Retinal fundus photograph; 2346x1568px; 45-degree field of view.
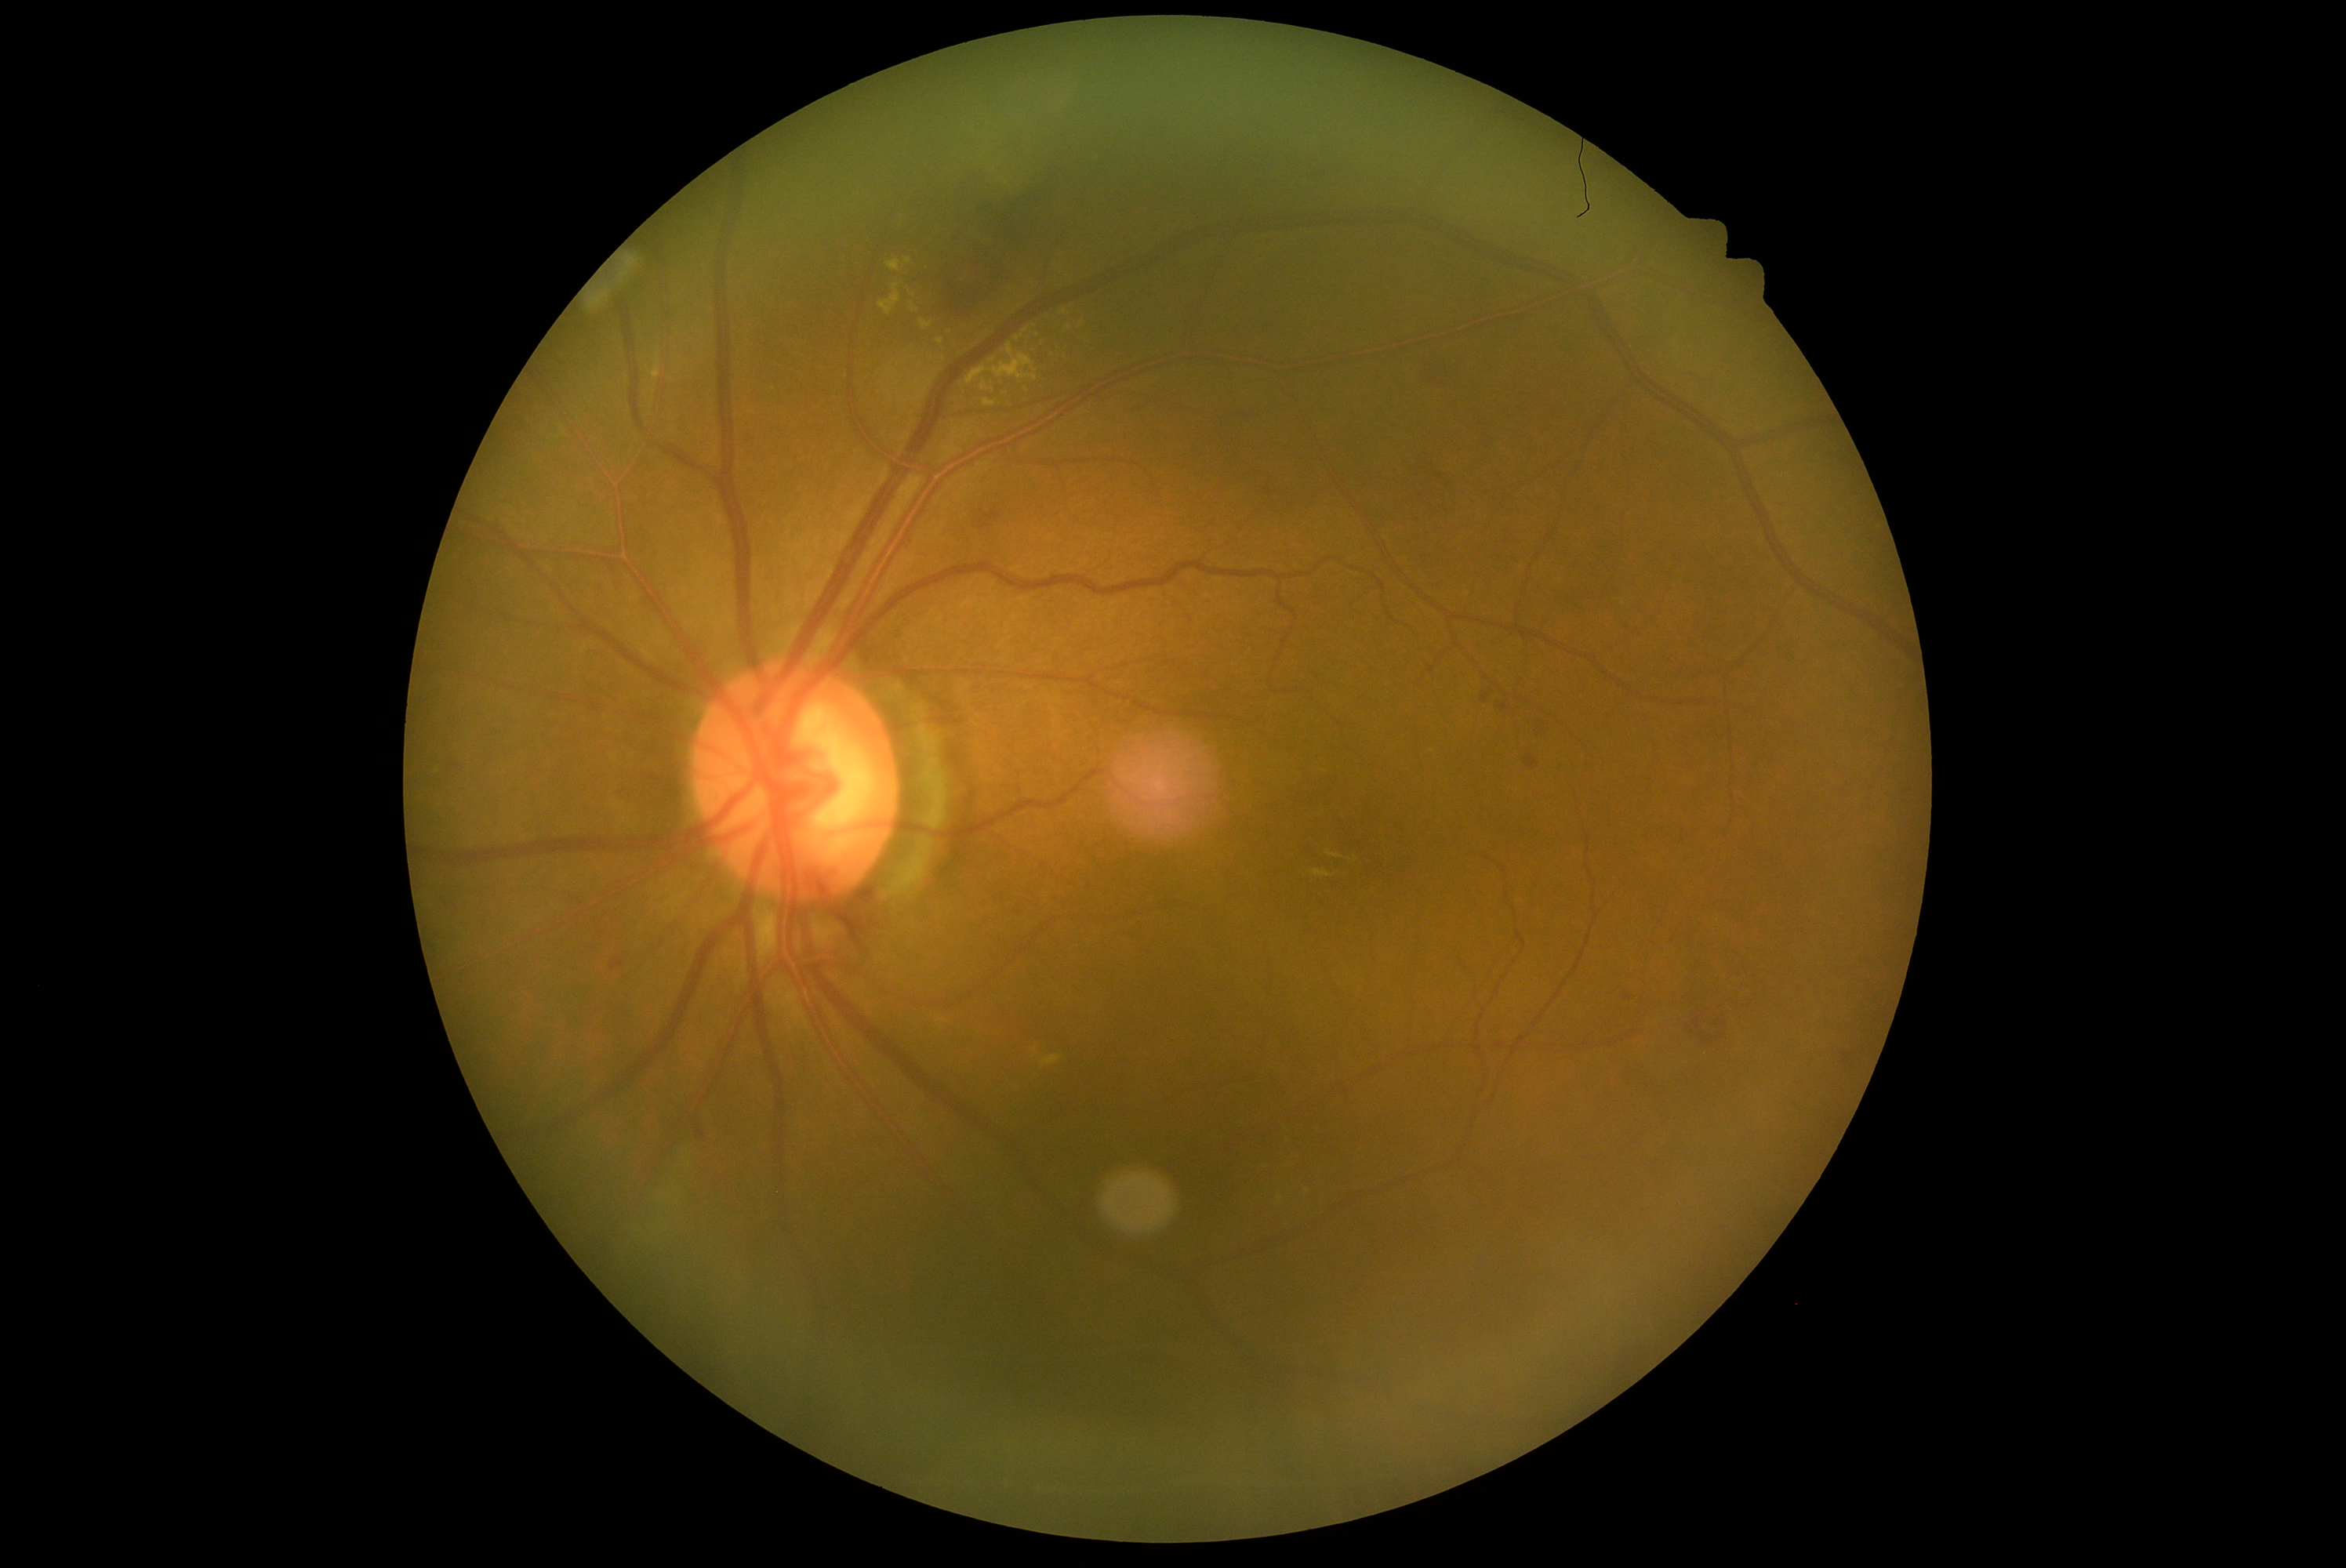
Diabetic retinopathy: moderate NPDR (grade 2). Hard exudates include those at BBox(982, 399, 997, 408) | BBox(879, 283, 901, 316) | BBox(1015, 328, 1028, 343) | BBox(1034, 1048, 1040, 1058) | BBox(1040, 1054, 1061, 1069) | BBox(909, 302, 918, 313). Hard exudates (small, approximate centers) near 1069, 328 | 1064, 313 | 1082, 324 | 1308, 1190. Hemorrhages include those at BBox(611, 956, 634, 975) | BBox(1476, 677, 1497, 705) | BBox(1409, 510, 1425, 526) | BBox(1125, 407, 1147, 415) | BBox(695, 1127, 705, 1141) | BBox(1487, 637, 1505, 652) | BBox(1412, 352, 1458, 391) | BBox(810, 876, 895, 960) | BBox(609, 782, 641, 808) | BBox(1494, 697, 1520, 716) | BBox(976, 507, 1001, 529) | BBox(1624, 993, 1632, 1001). Hemorrhages (small, approximate centers) near 1849, 1063.